Image size 2352x1568.
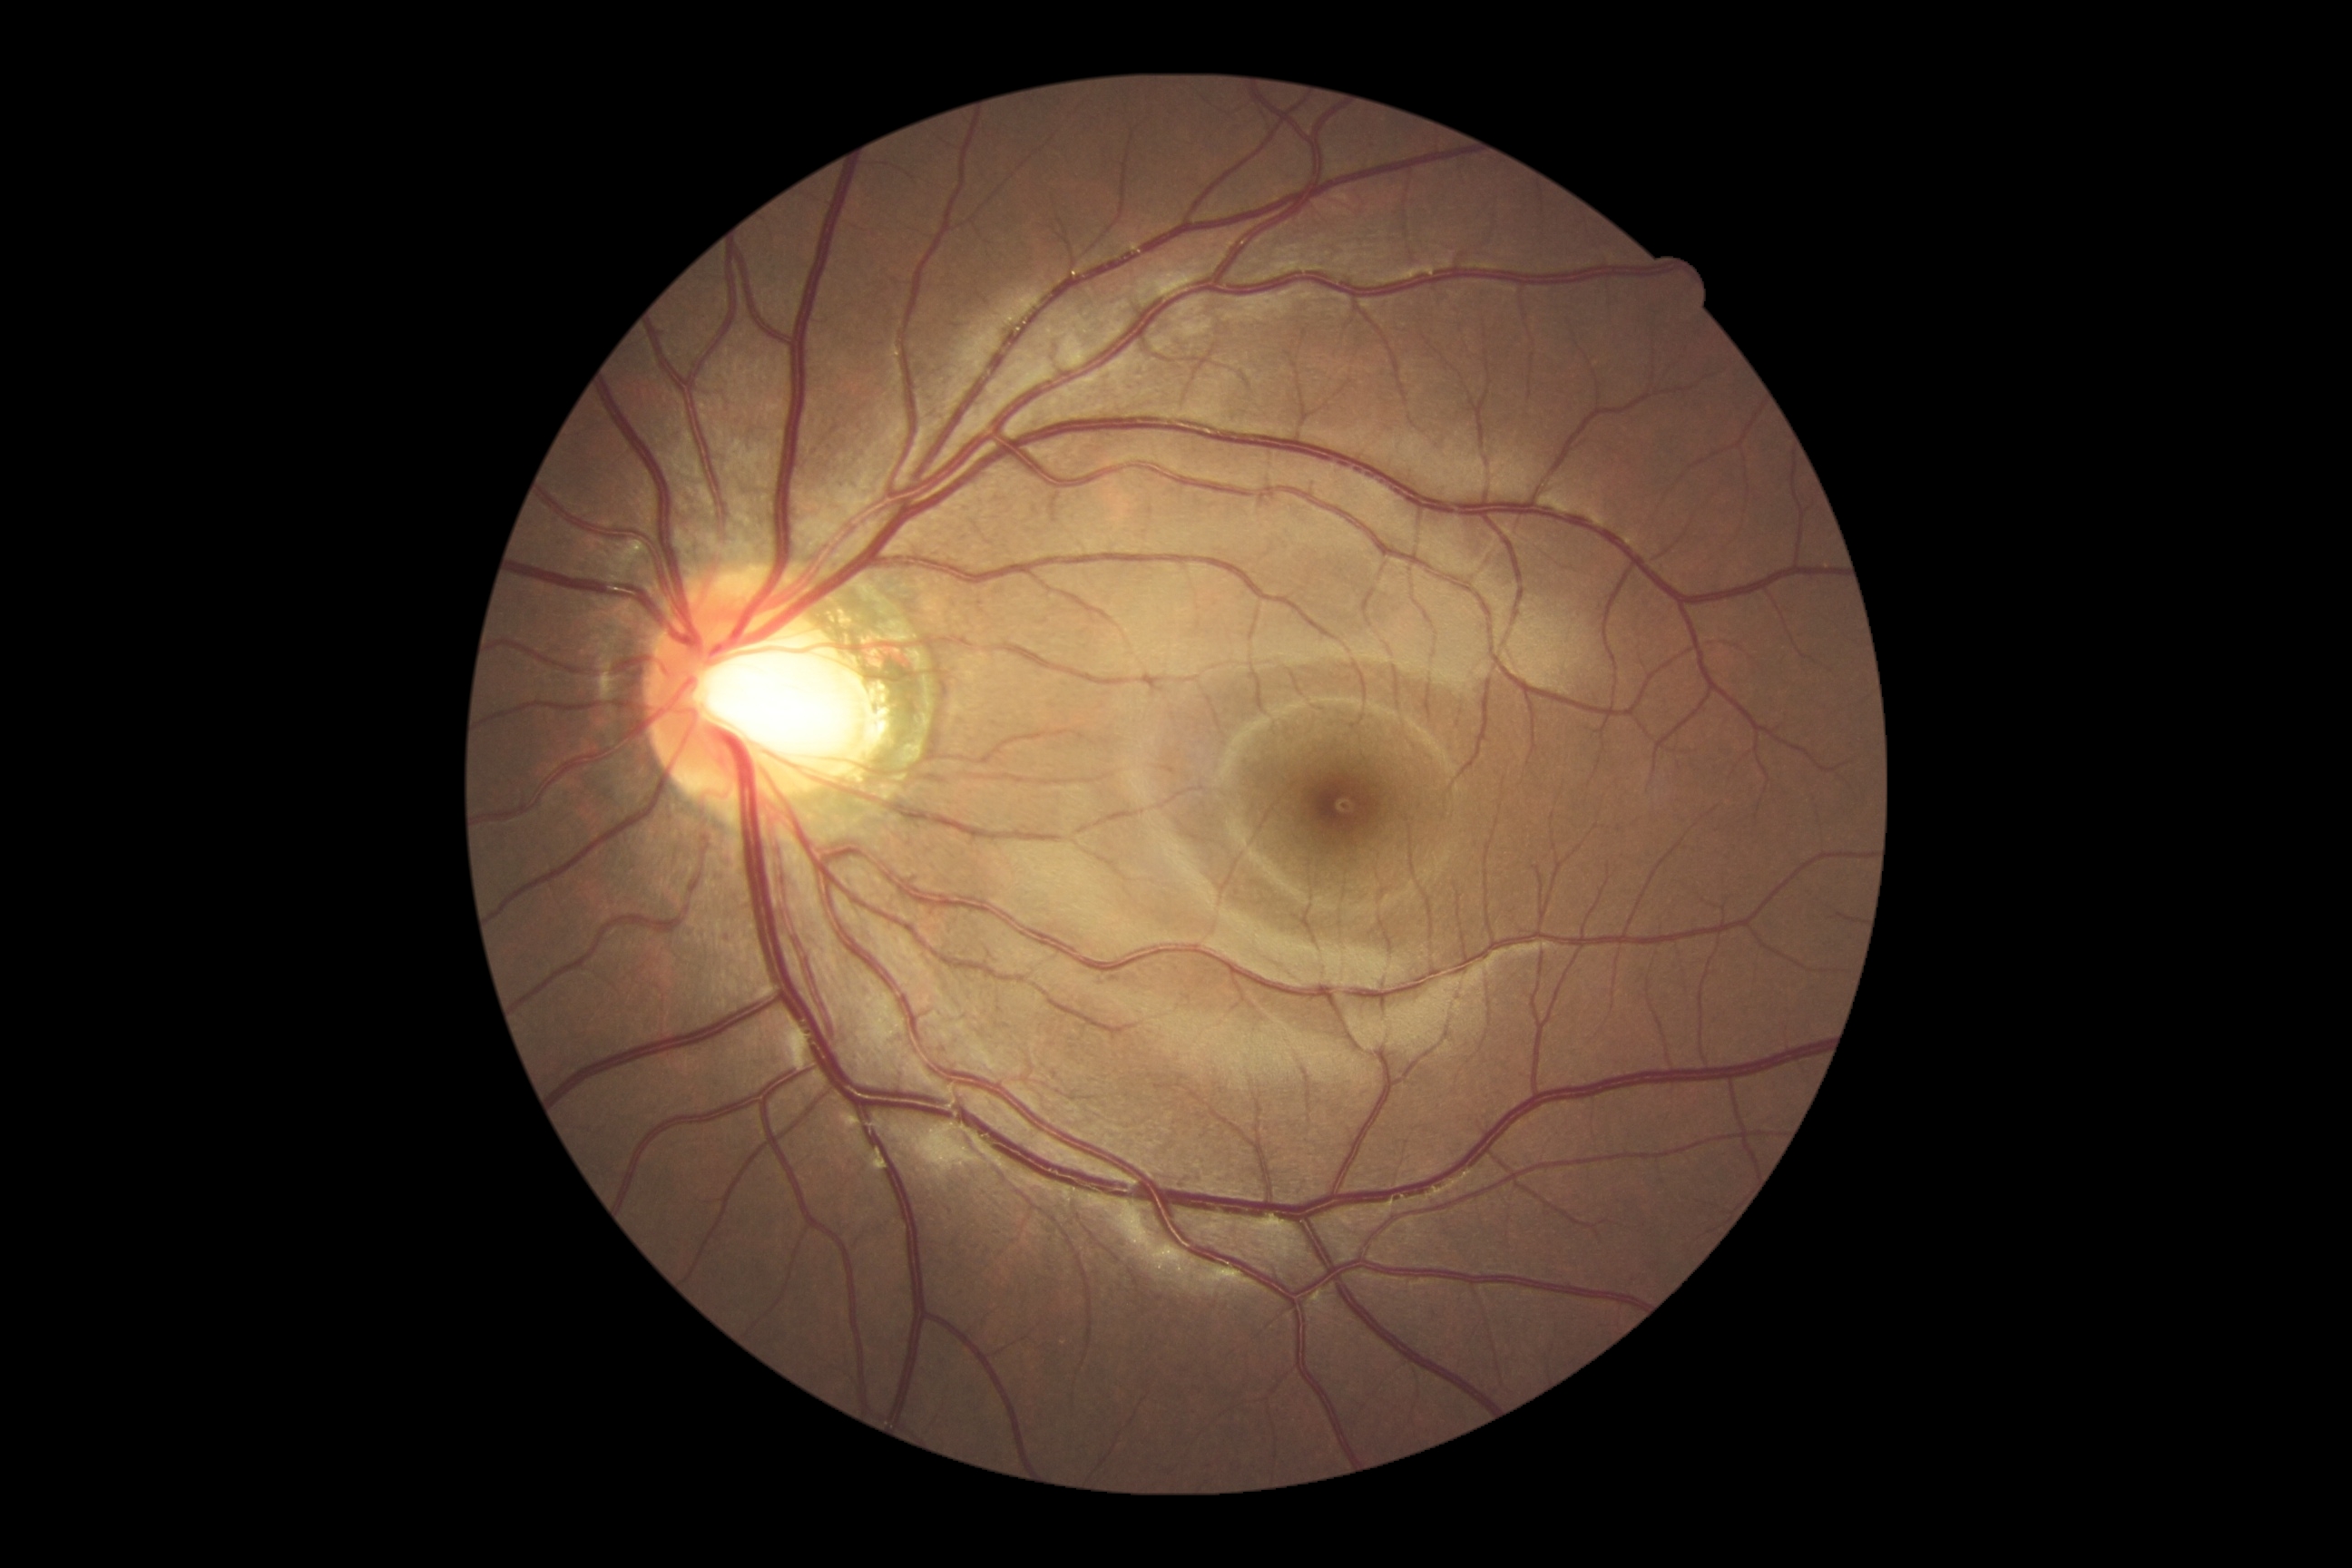 No diabetic retinal disease findings.
Diabetic retinopathy (DR) is grade 0 (no apparent retinopathy).